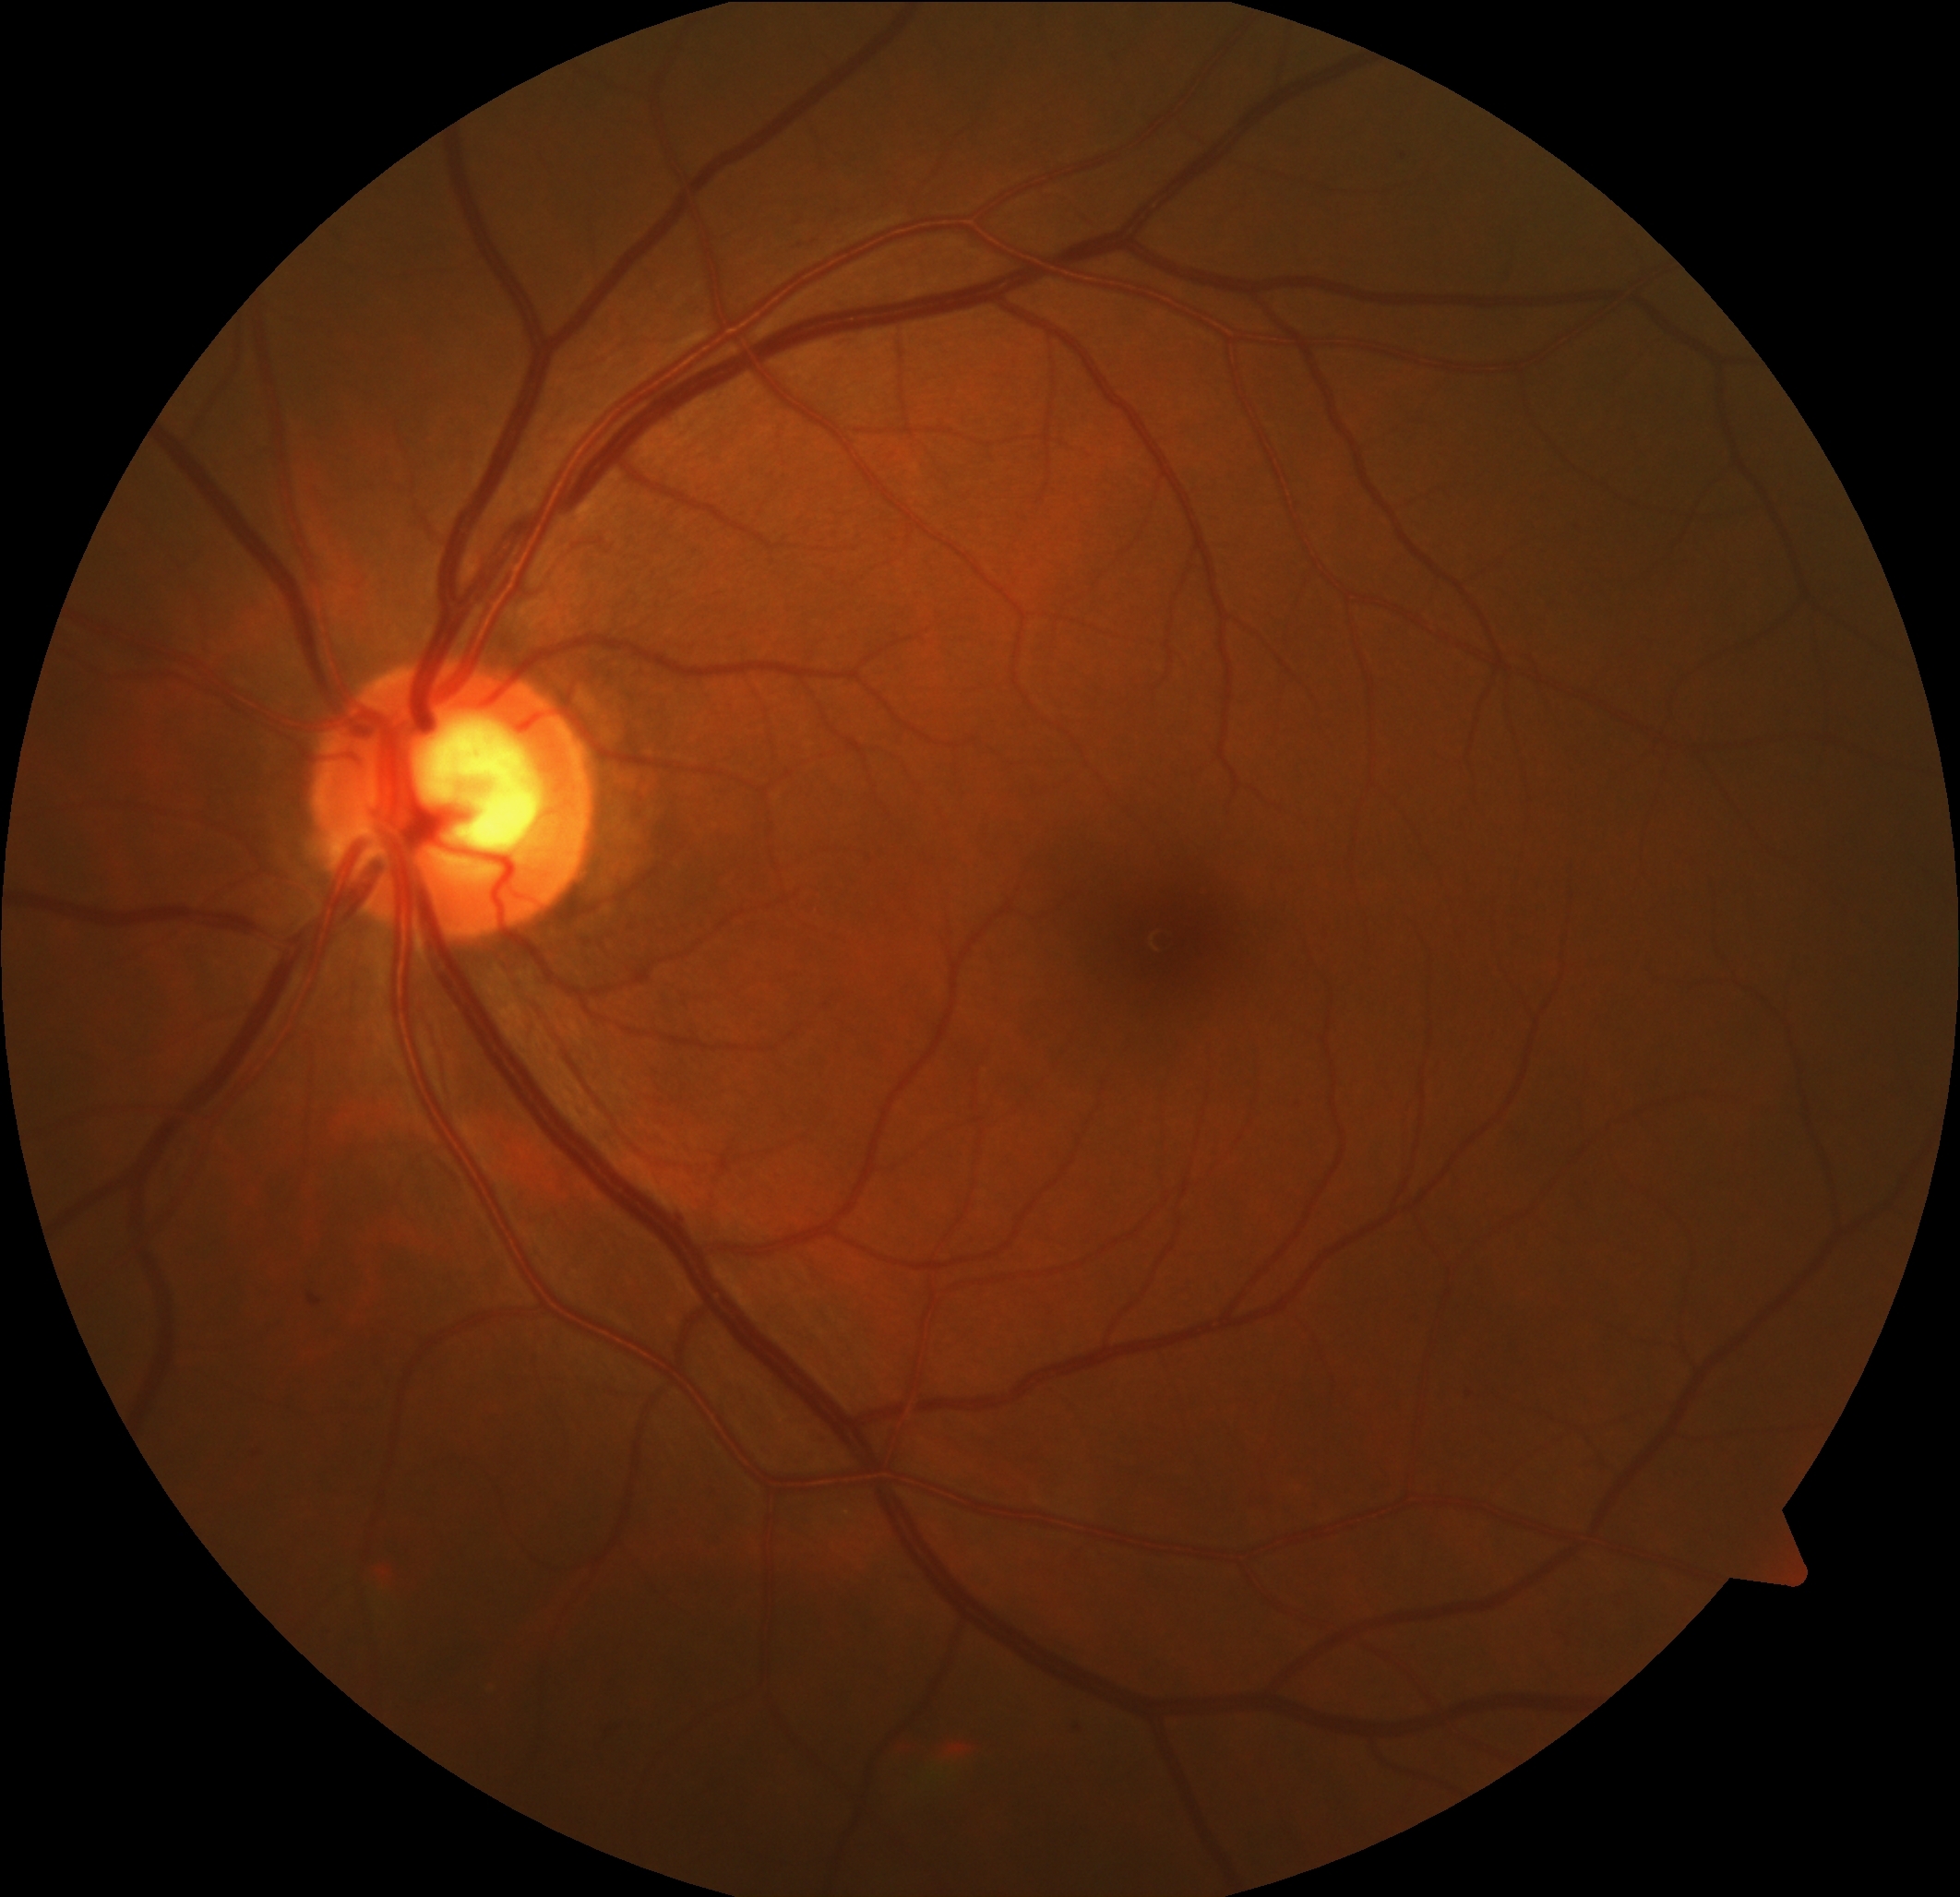
Diabetic retinopathy (DR) is mild non-proliferative diabetic retinopathy (grade 1).